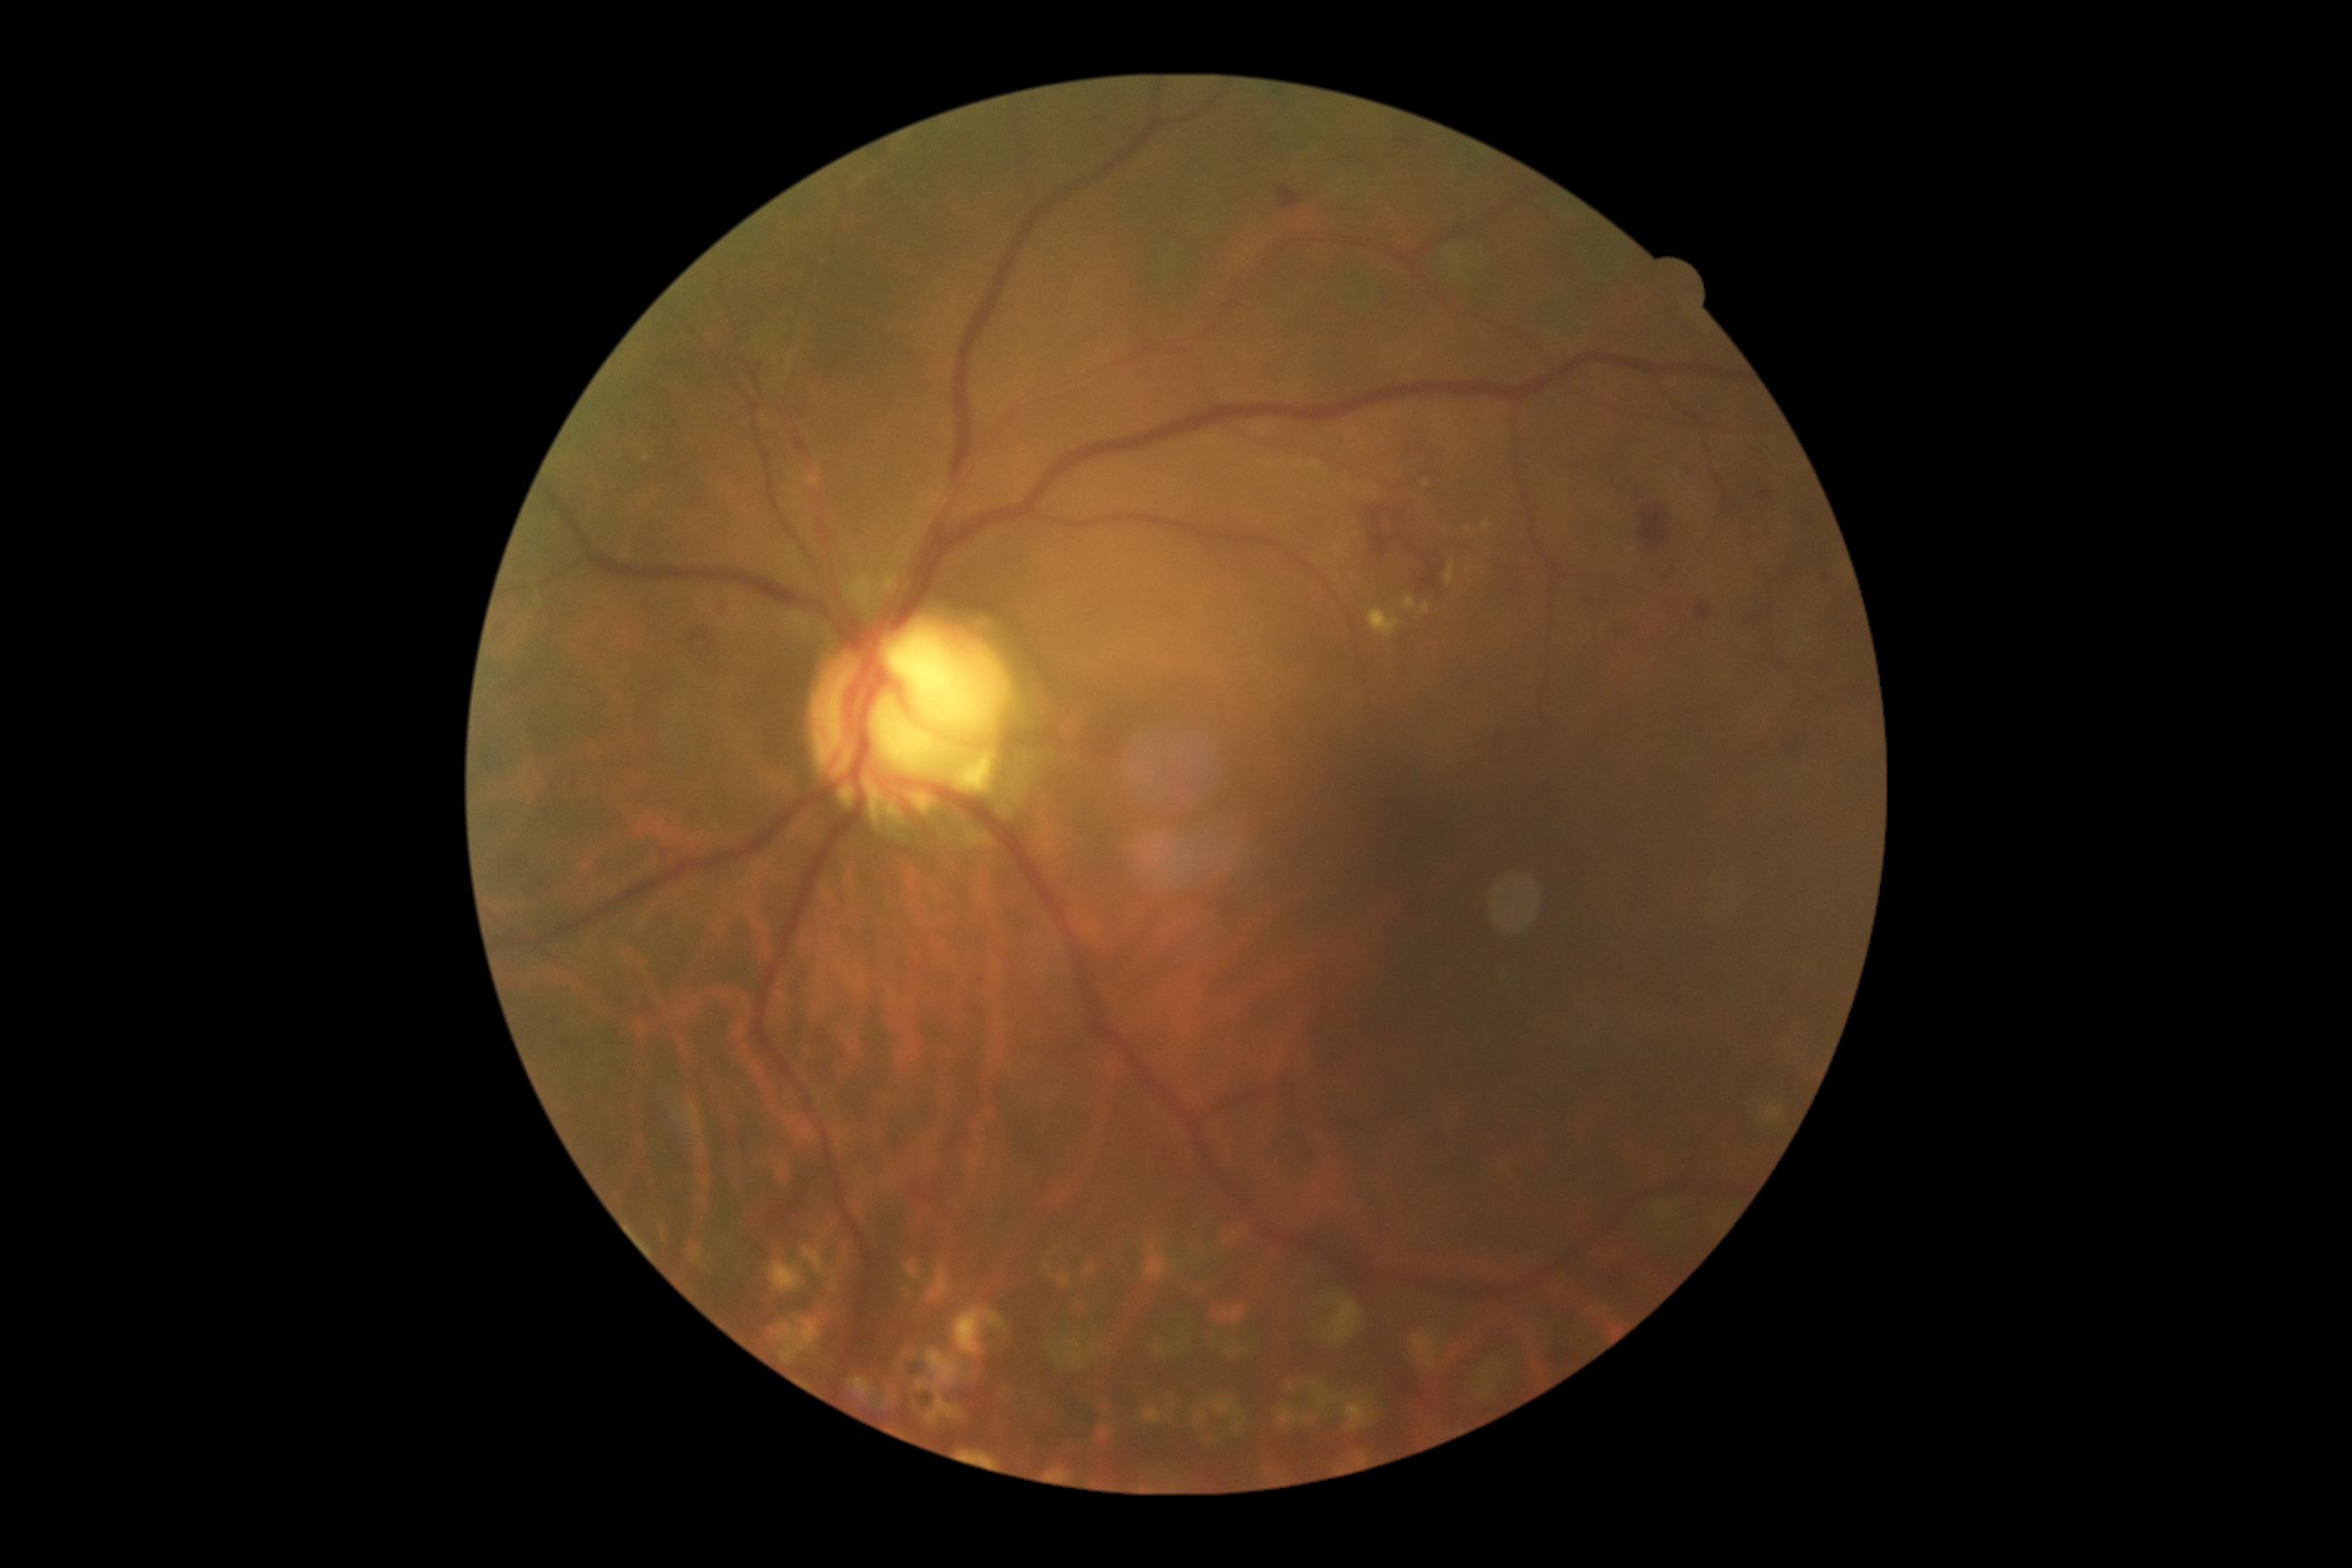
DR grade: 2/4.